Color fundus image, camera: Nidek AFC-330
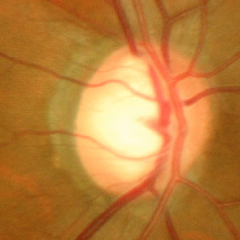
Assessment: severe glaucomatous damage.